45° FOV · 1932 by 1916 pixels — 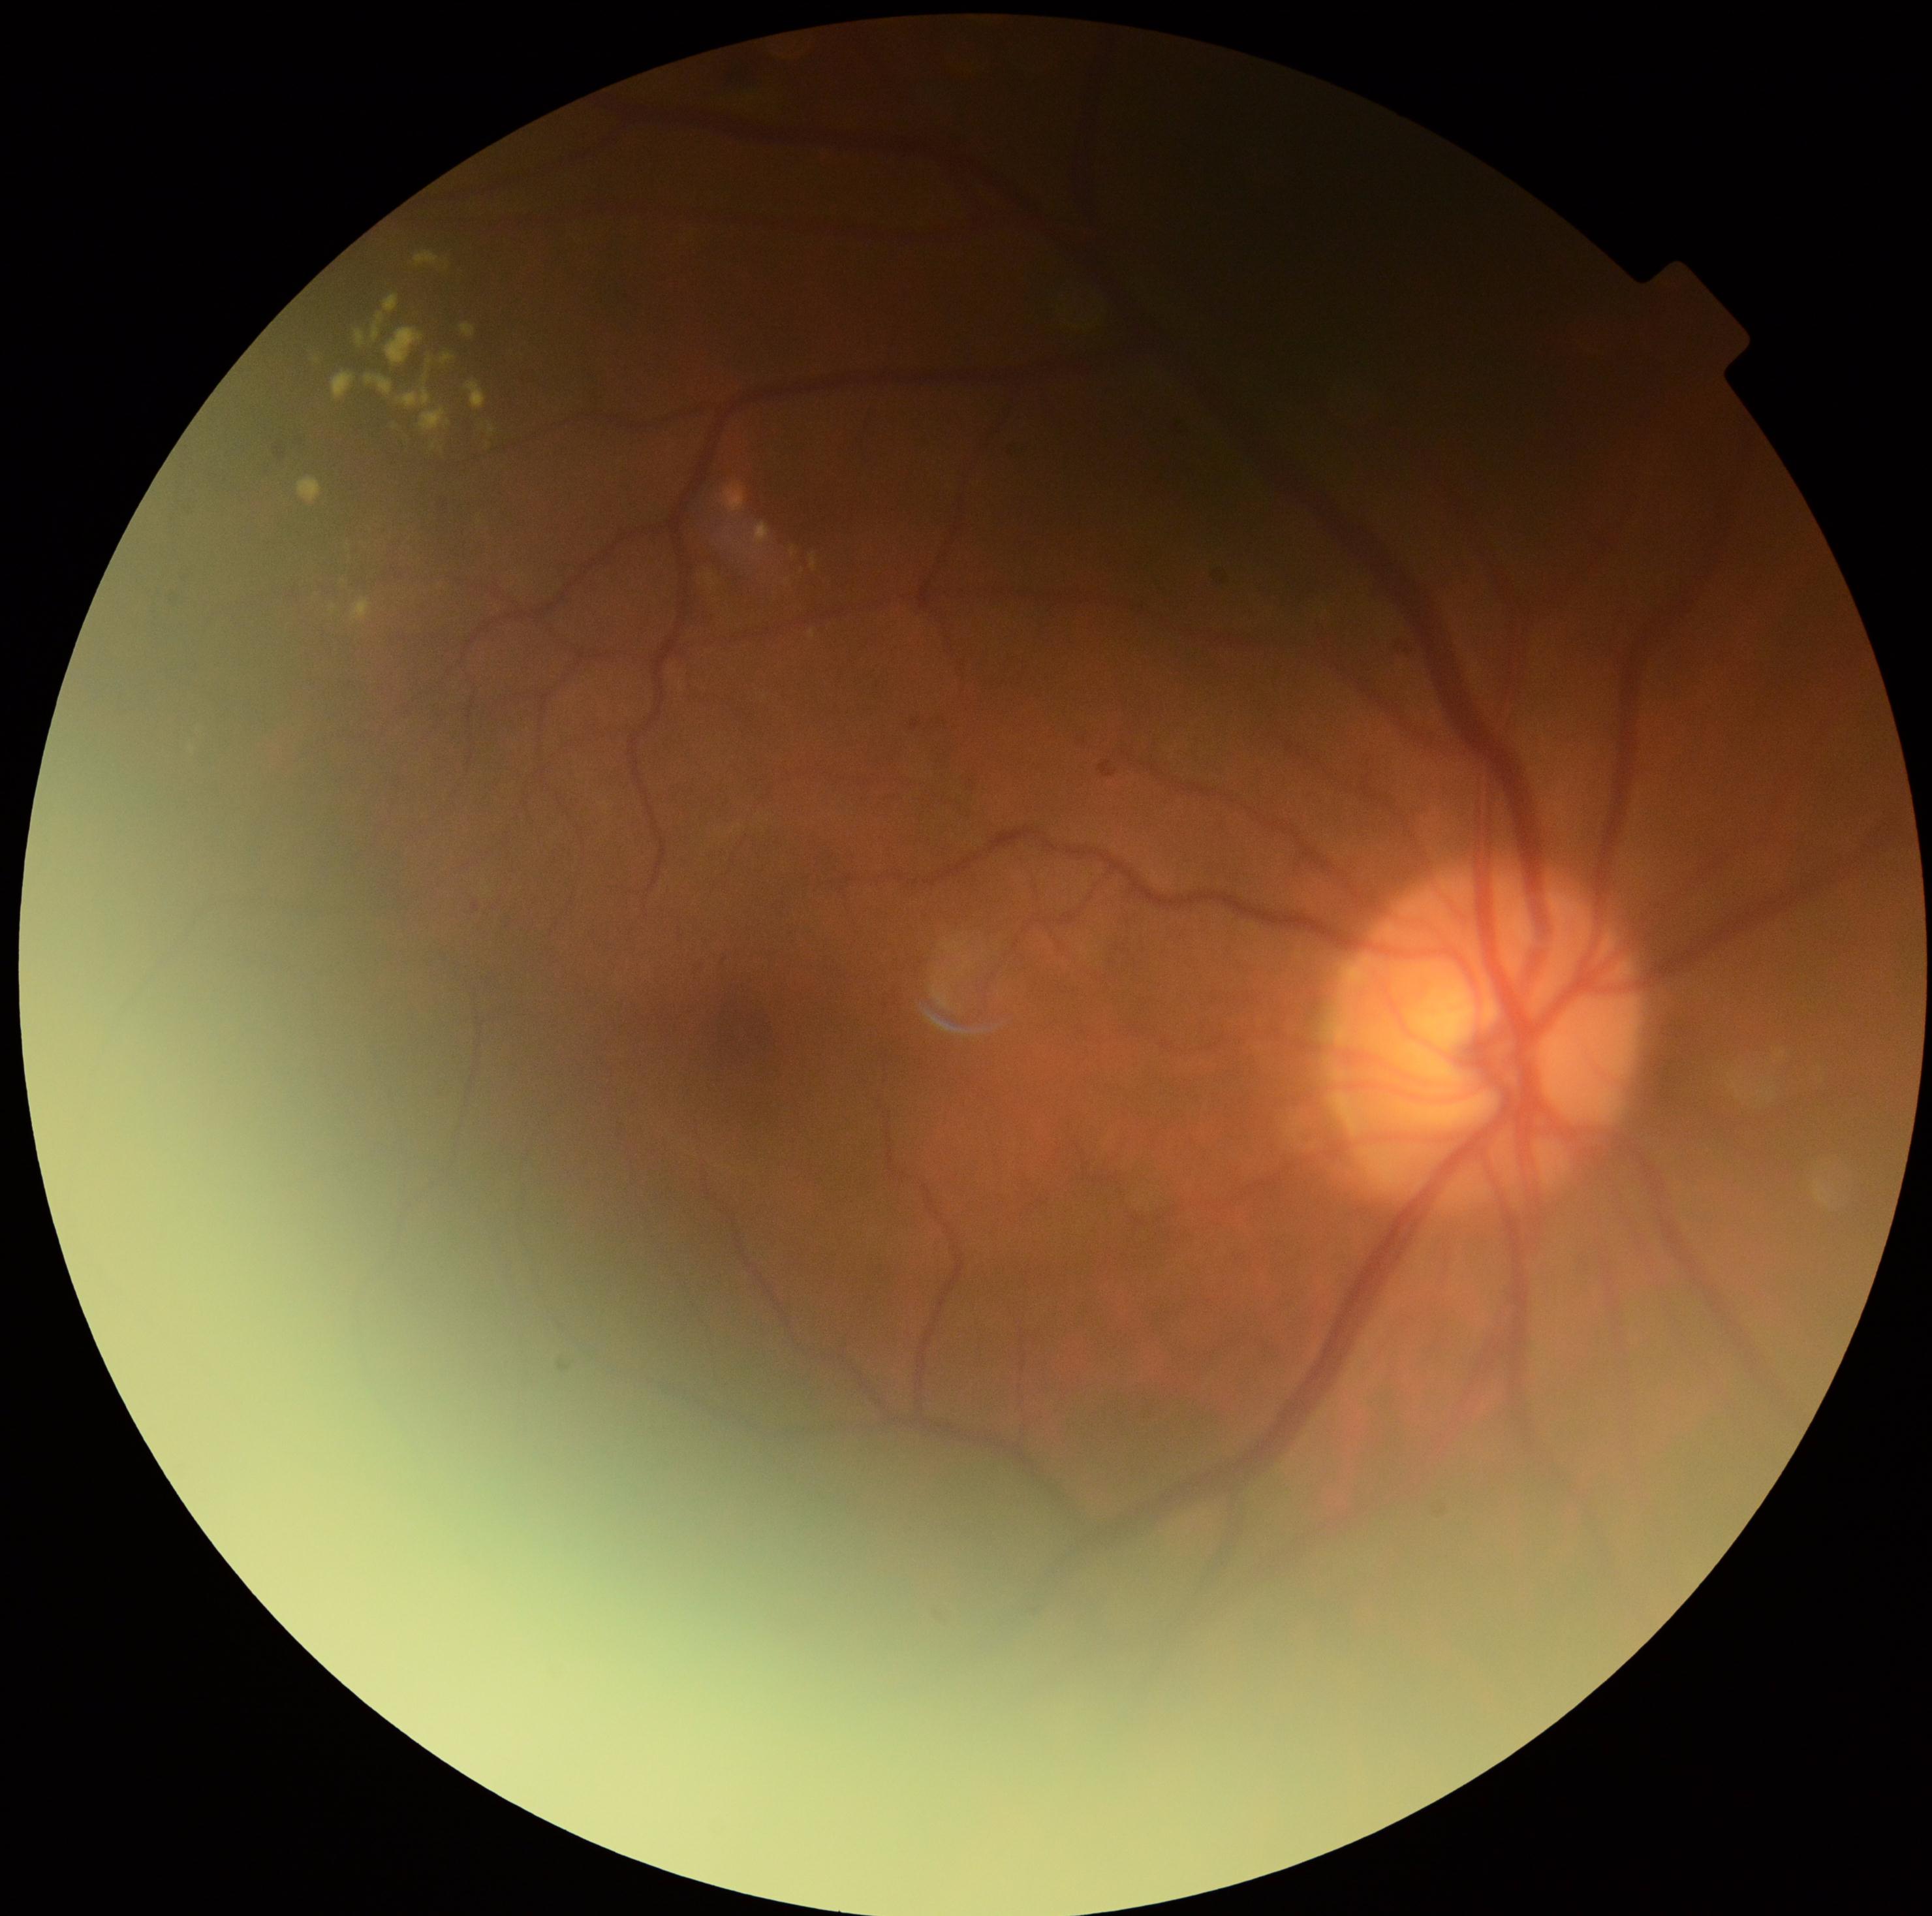 Diabetic retinopathy is 2.